2089x1764px: 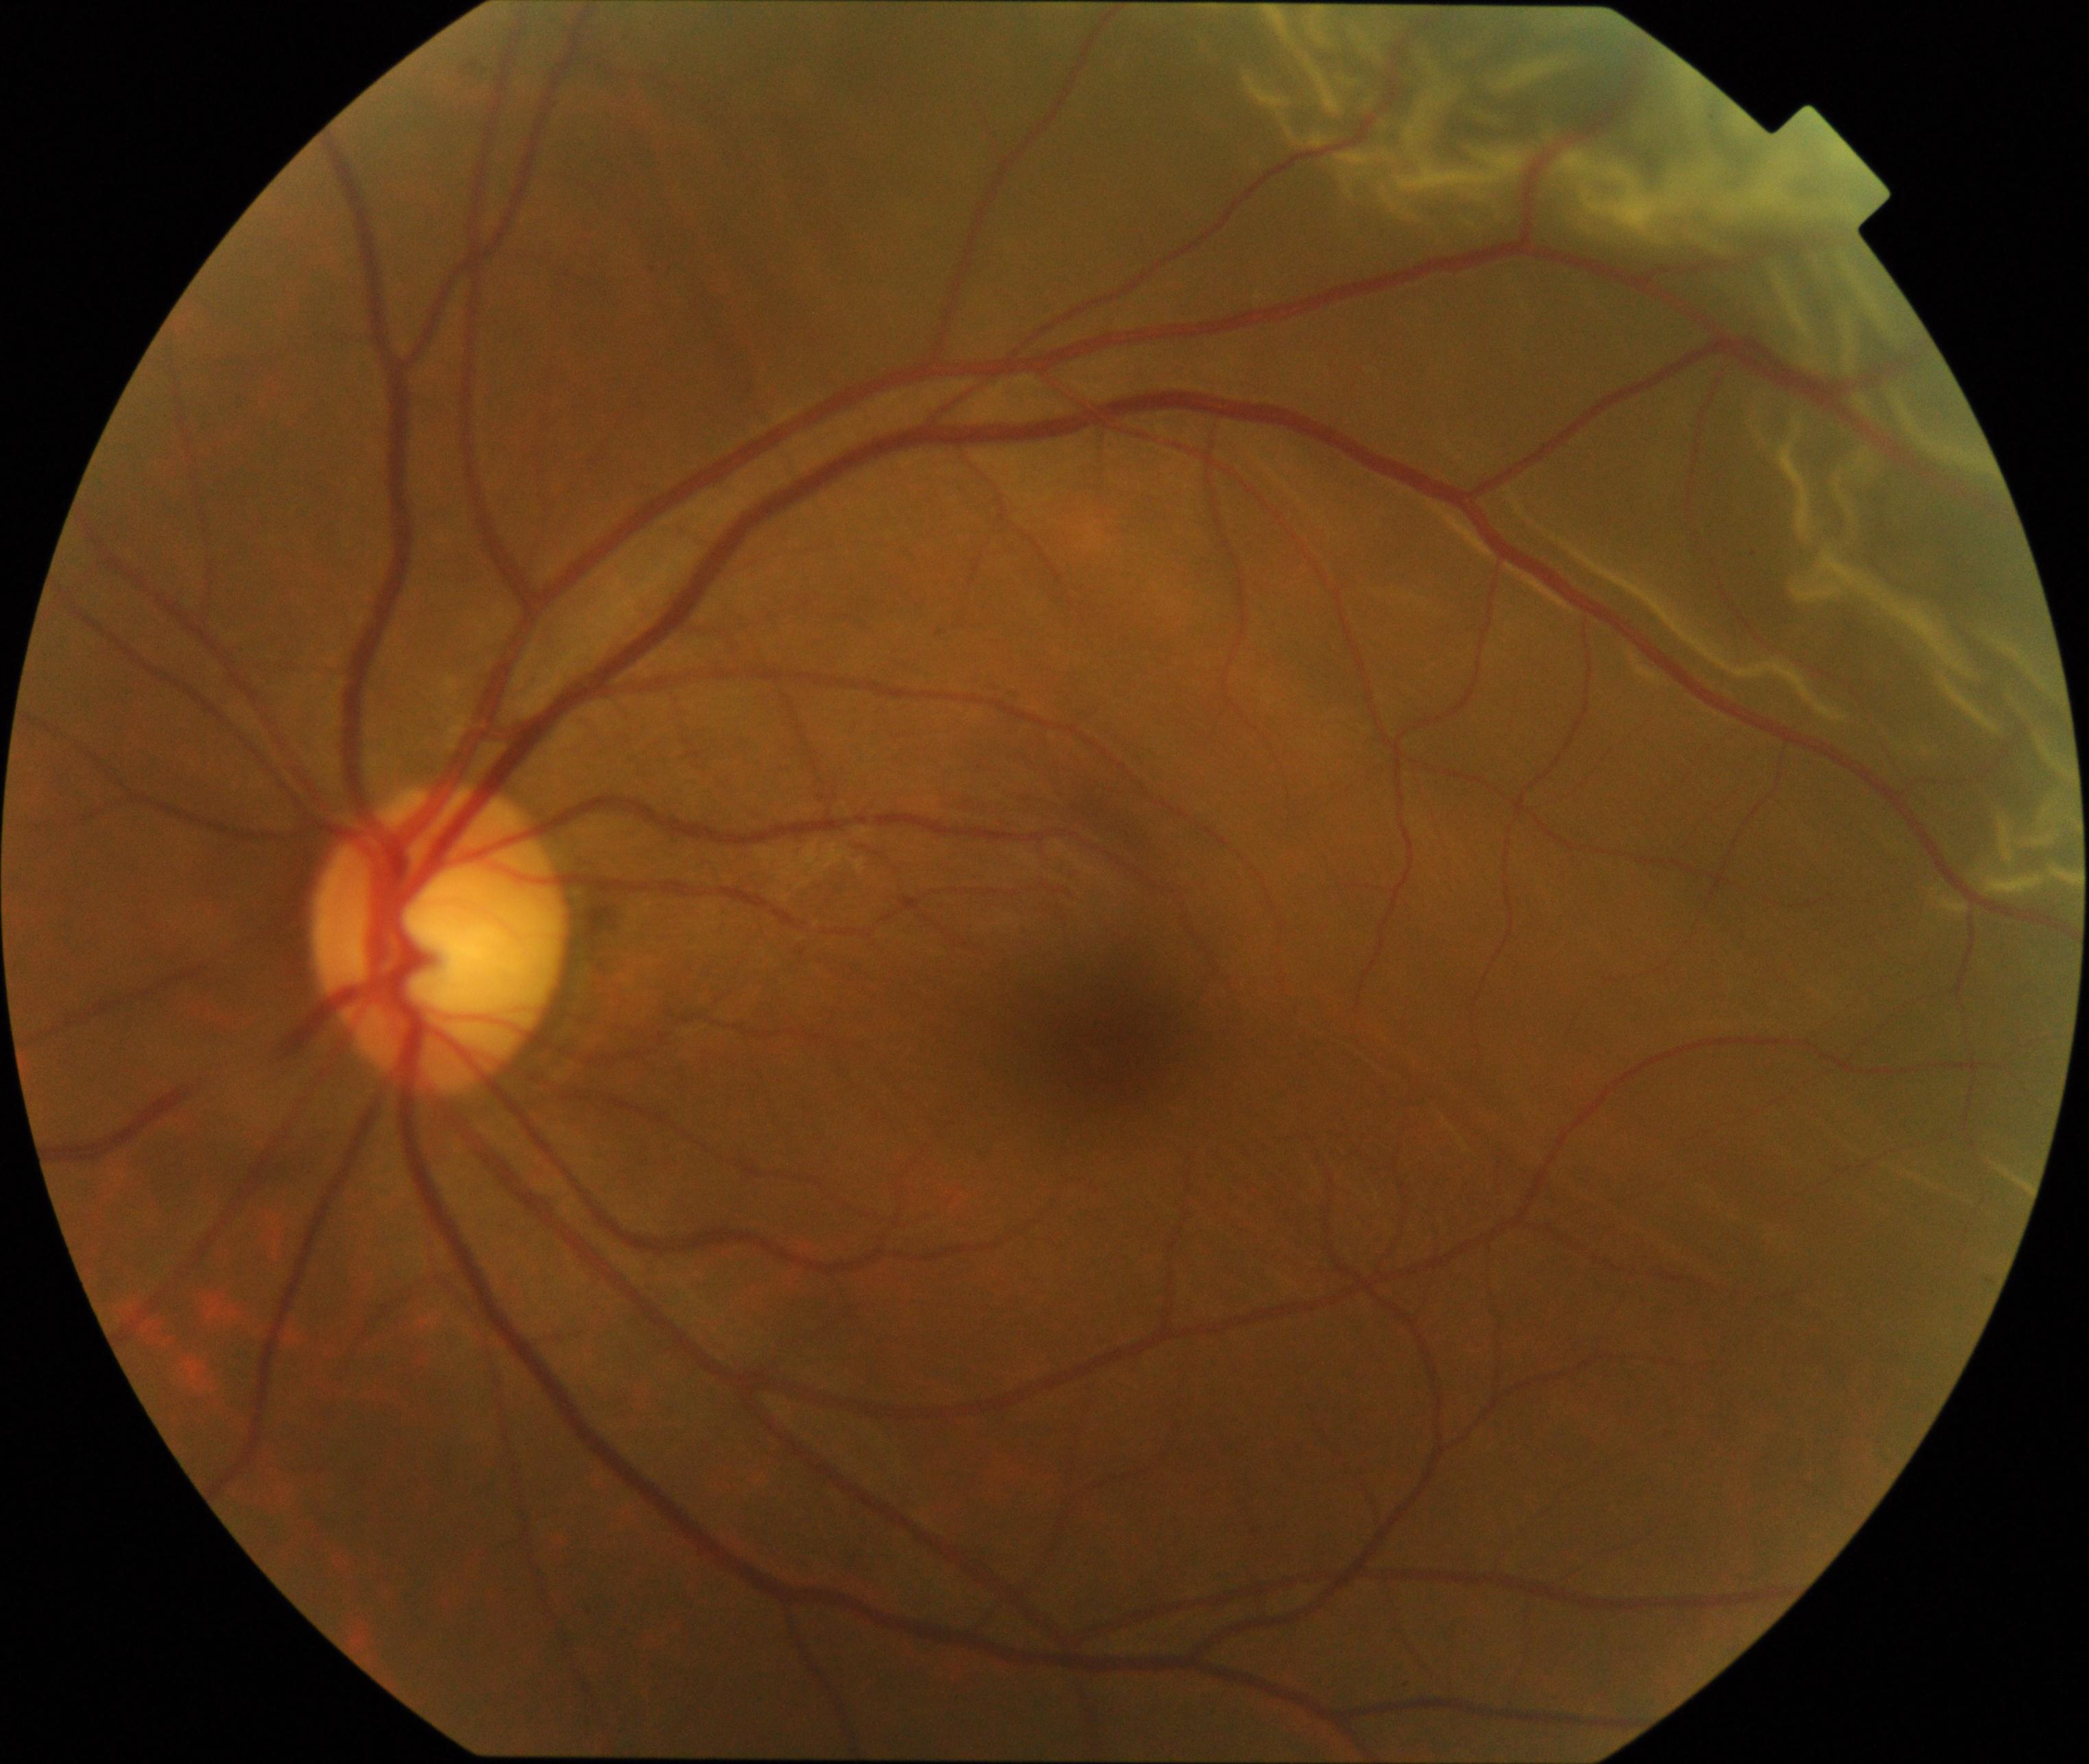 Findings consistent with rhegmatogenous retinal detachment. Features include slightly opaque, convex or corrugated appearance of elevated retina, sometimes with retinal breaks in view.